1920x1440 · CFP — 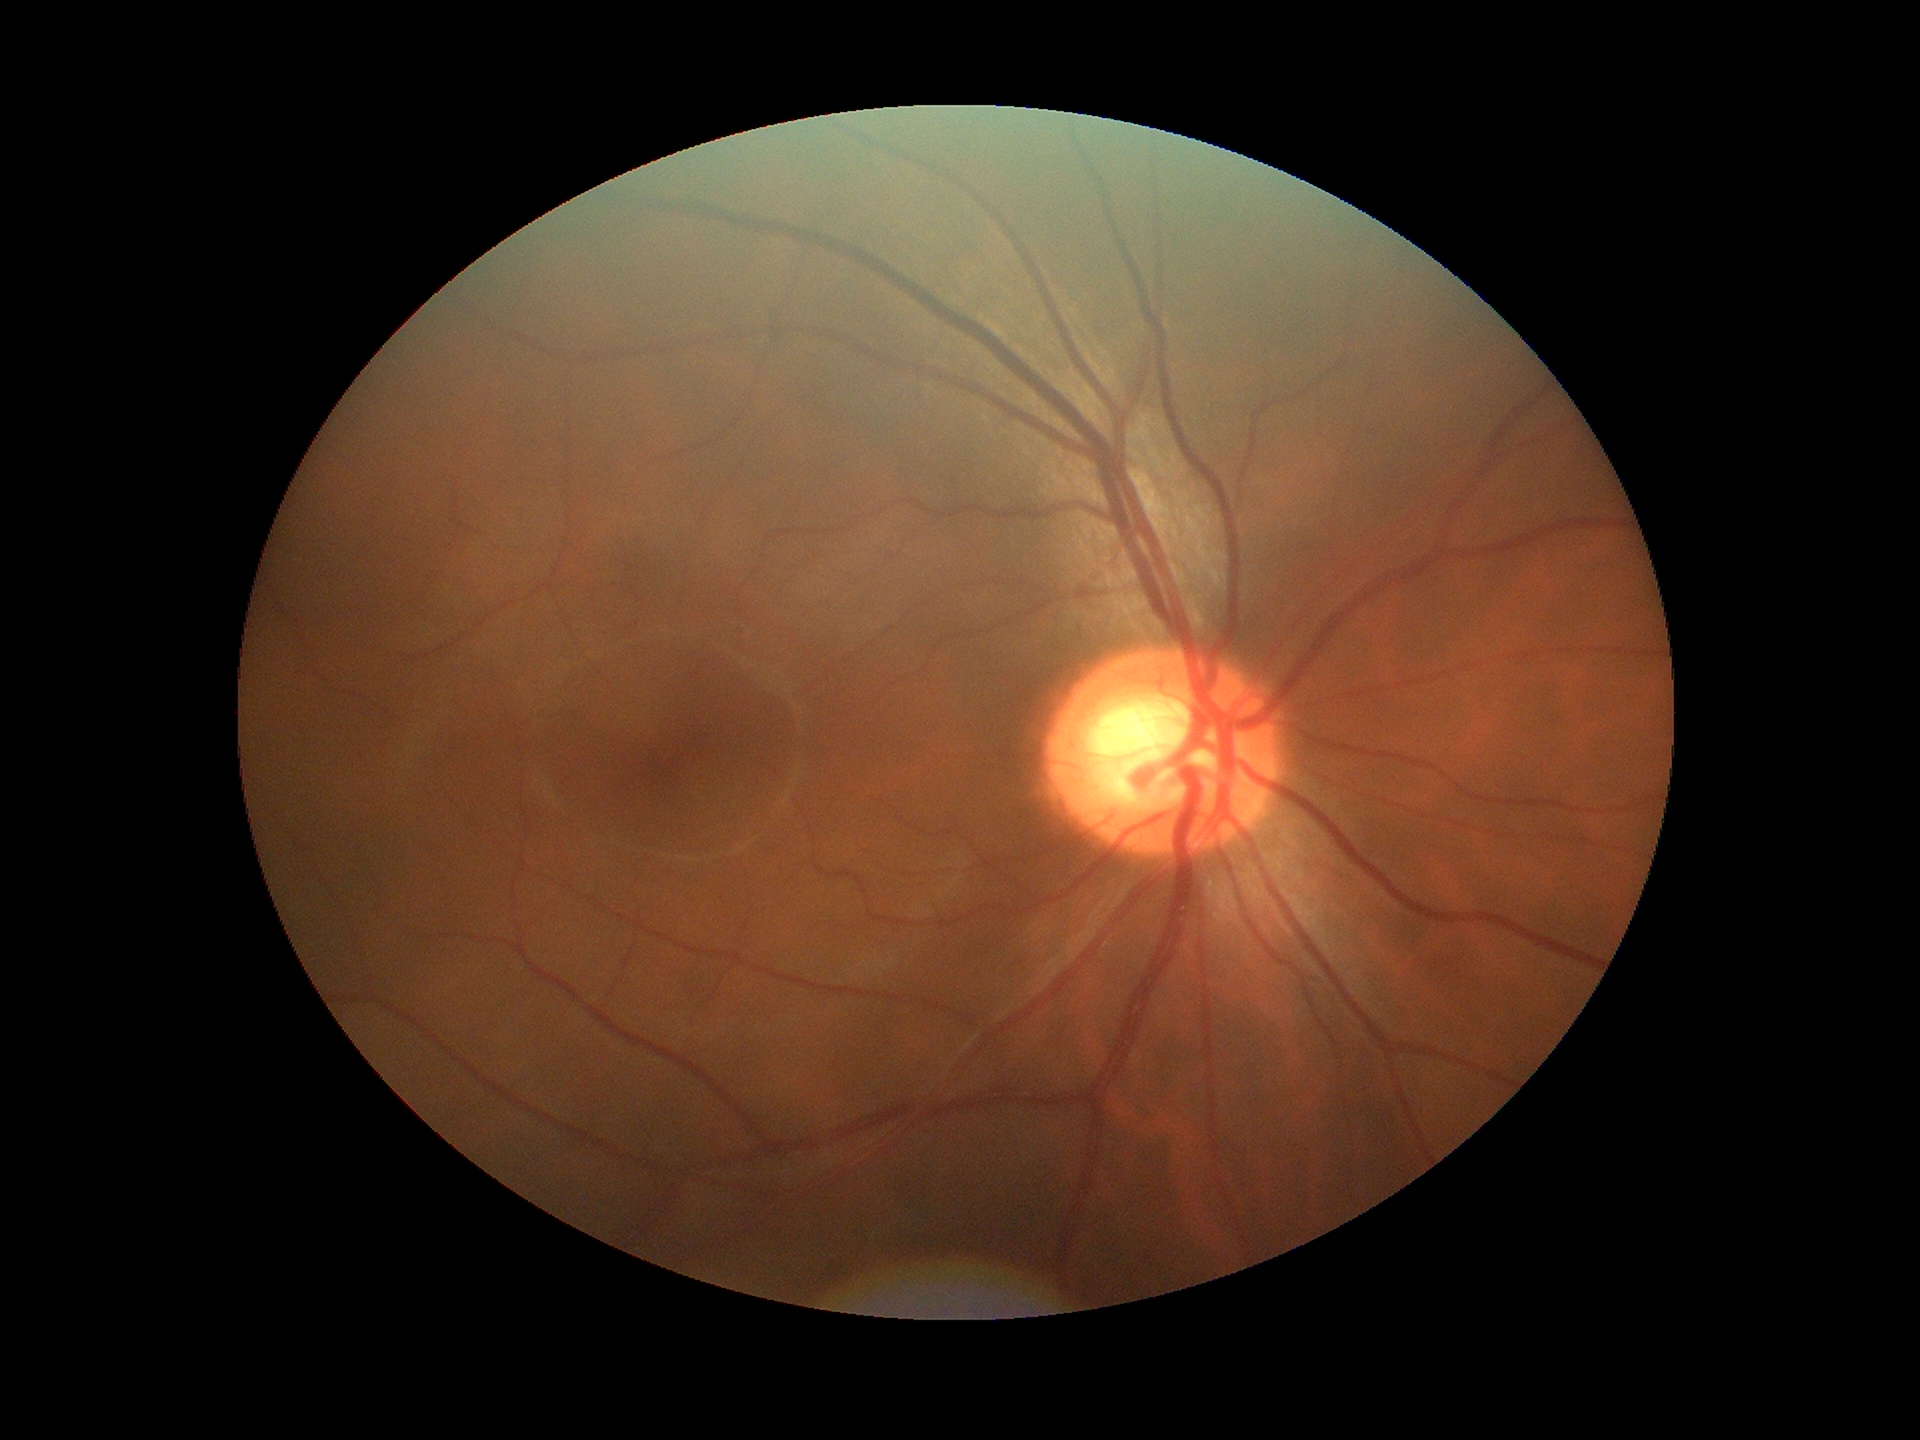
* Glaucoma evaluation — suspicious
* vertical C/D ratio — 0.67
* horizontal cup-to-disc ratio — 0.64